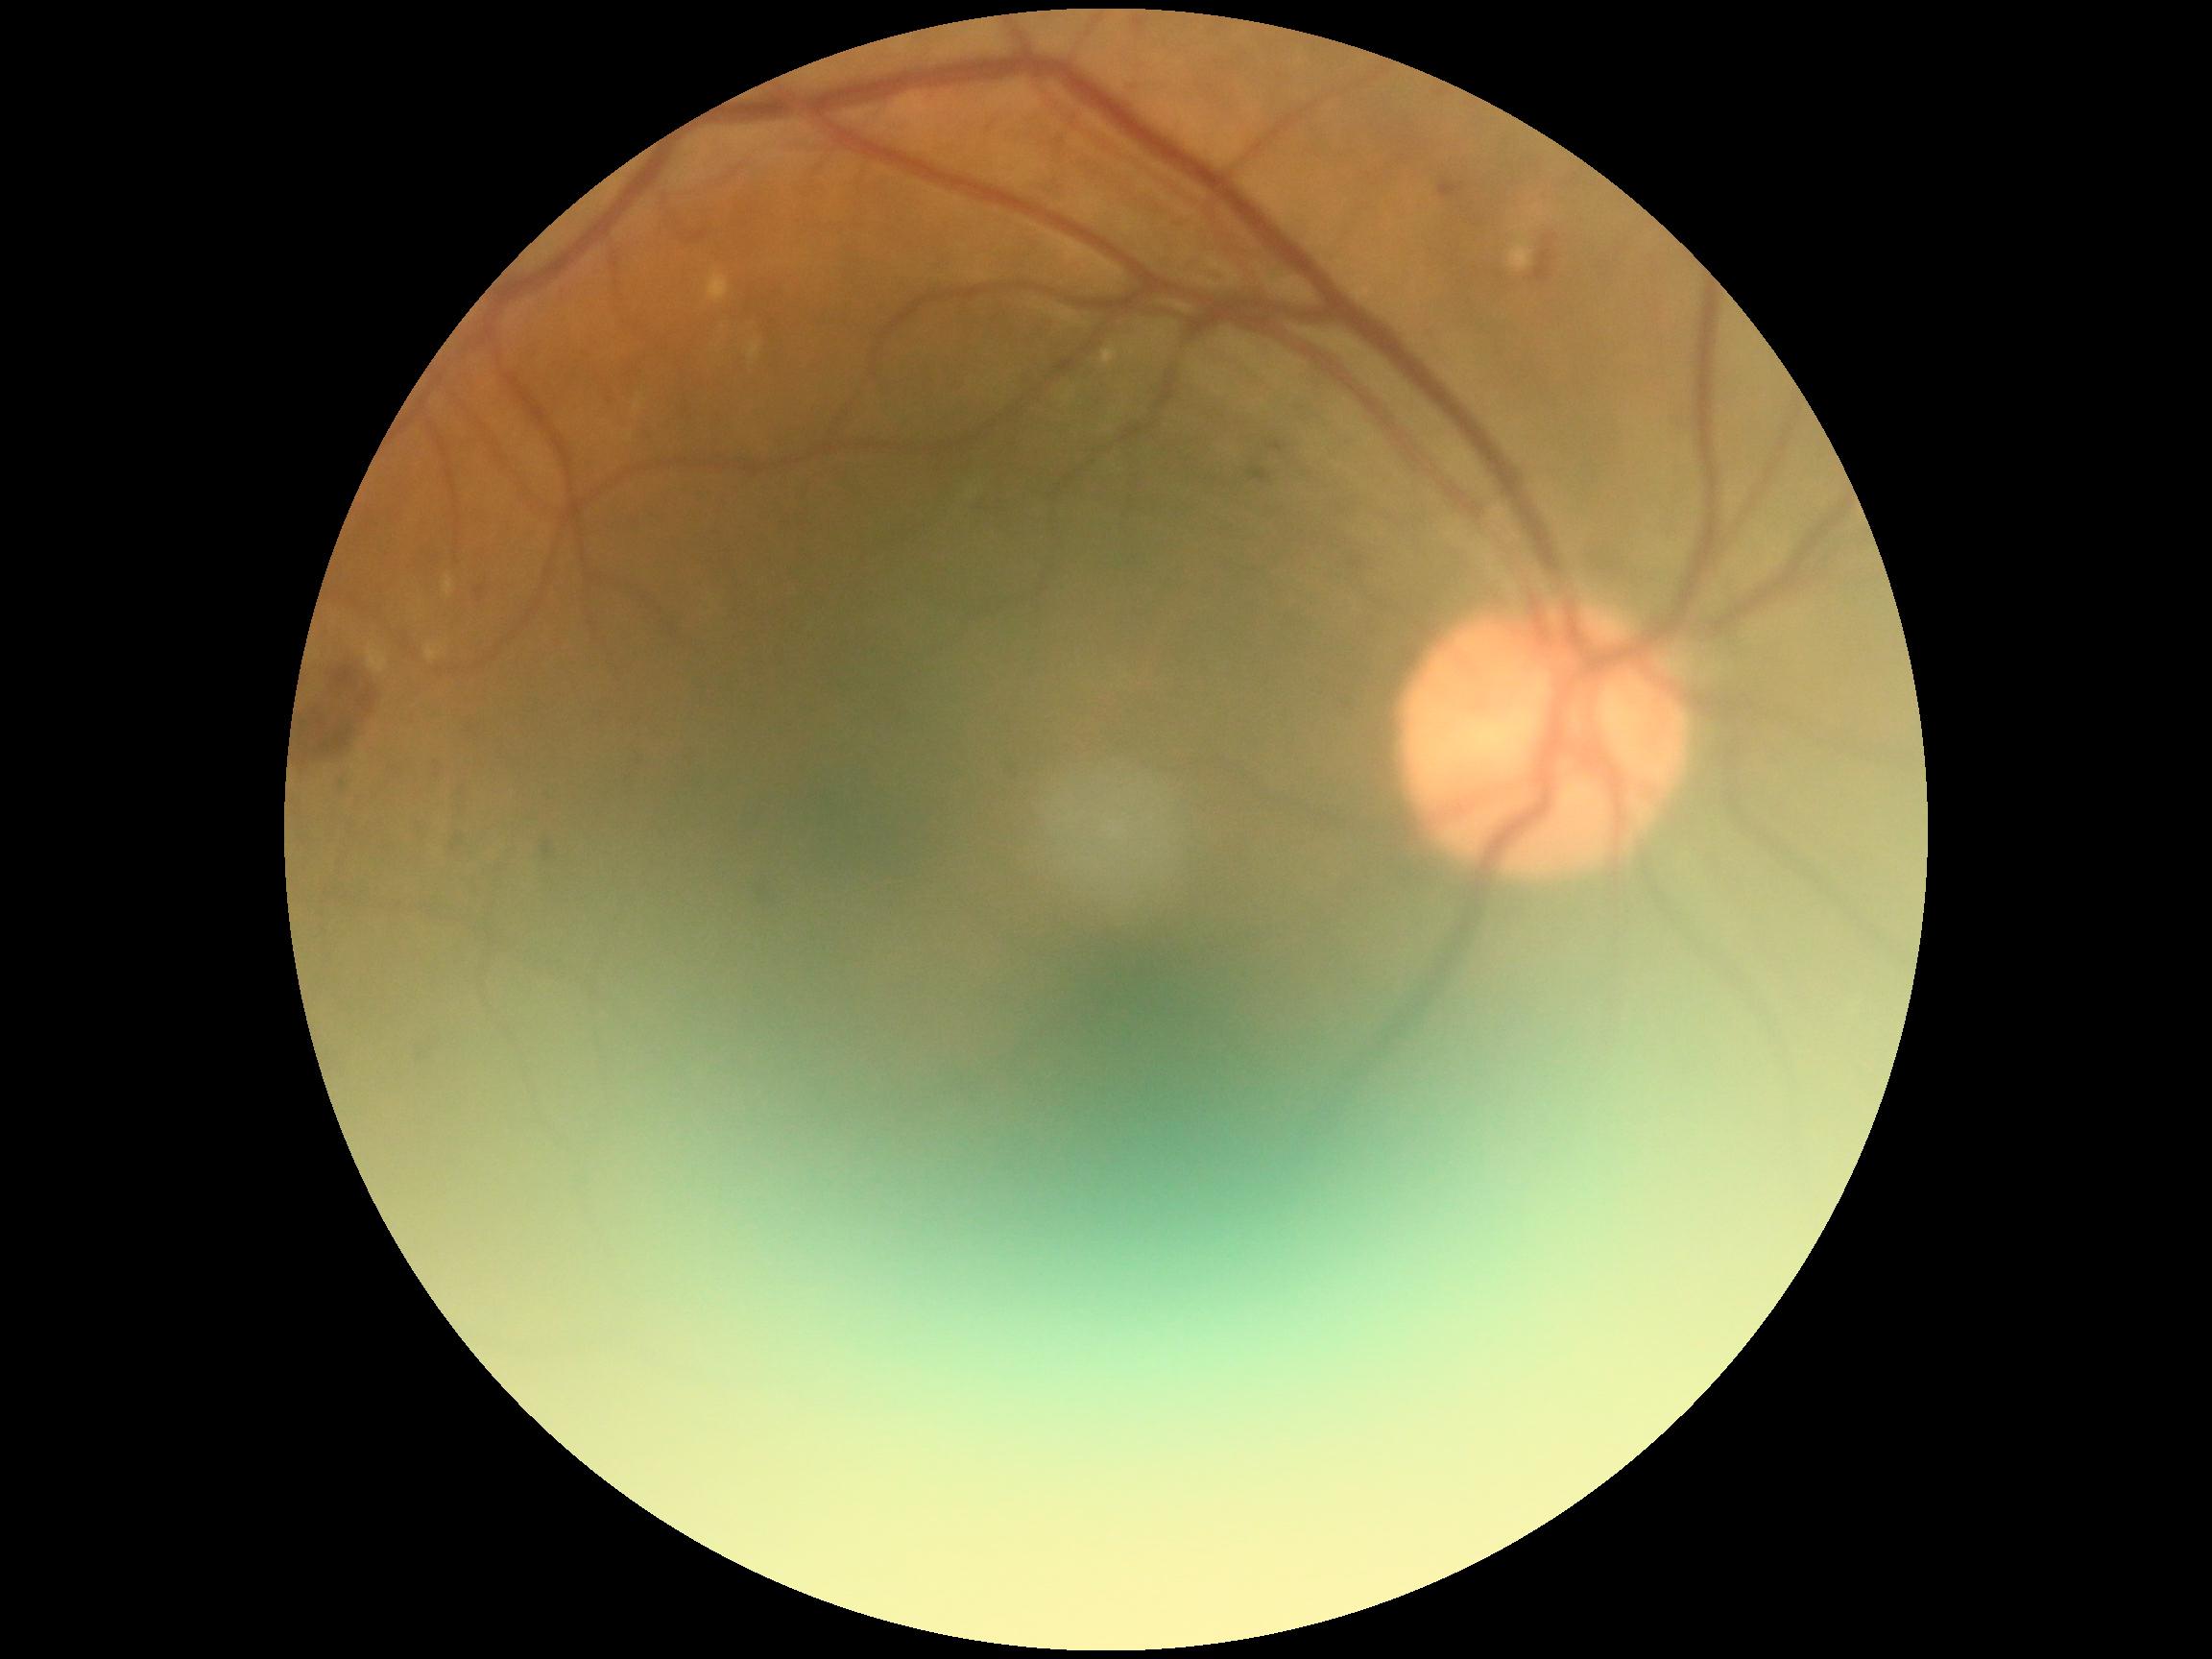

dr_grade: 2/4 — more than just microaneurysms but less than severe NPDR